Image size 2228x1652. CFP. Posterior pole field covering the optic disc and macula. 50° field of view. Captured after pupil dilation. Acquired with a Topcon TRC-50DX: 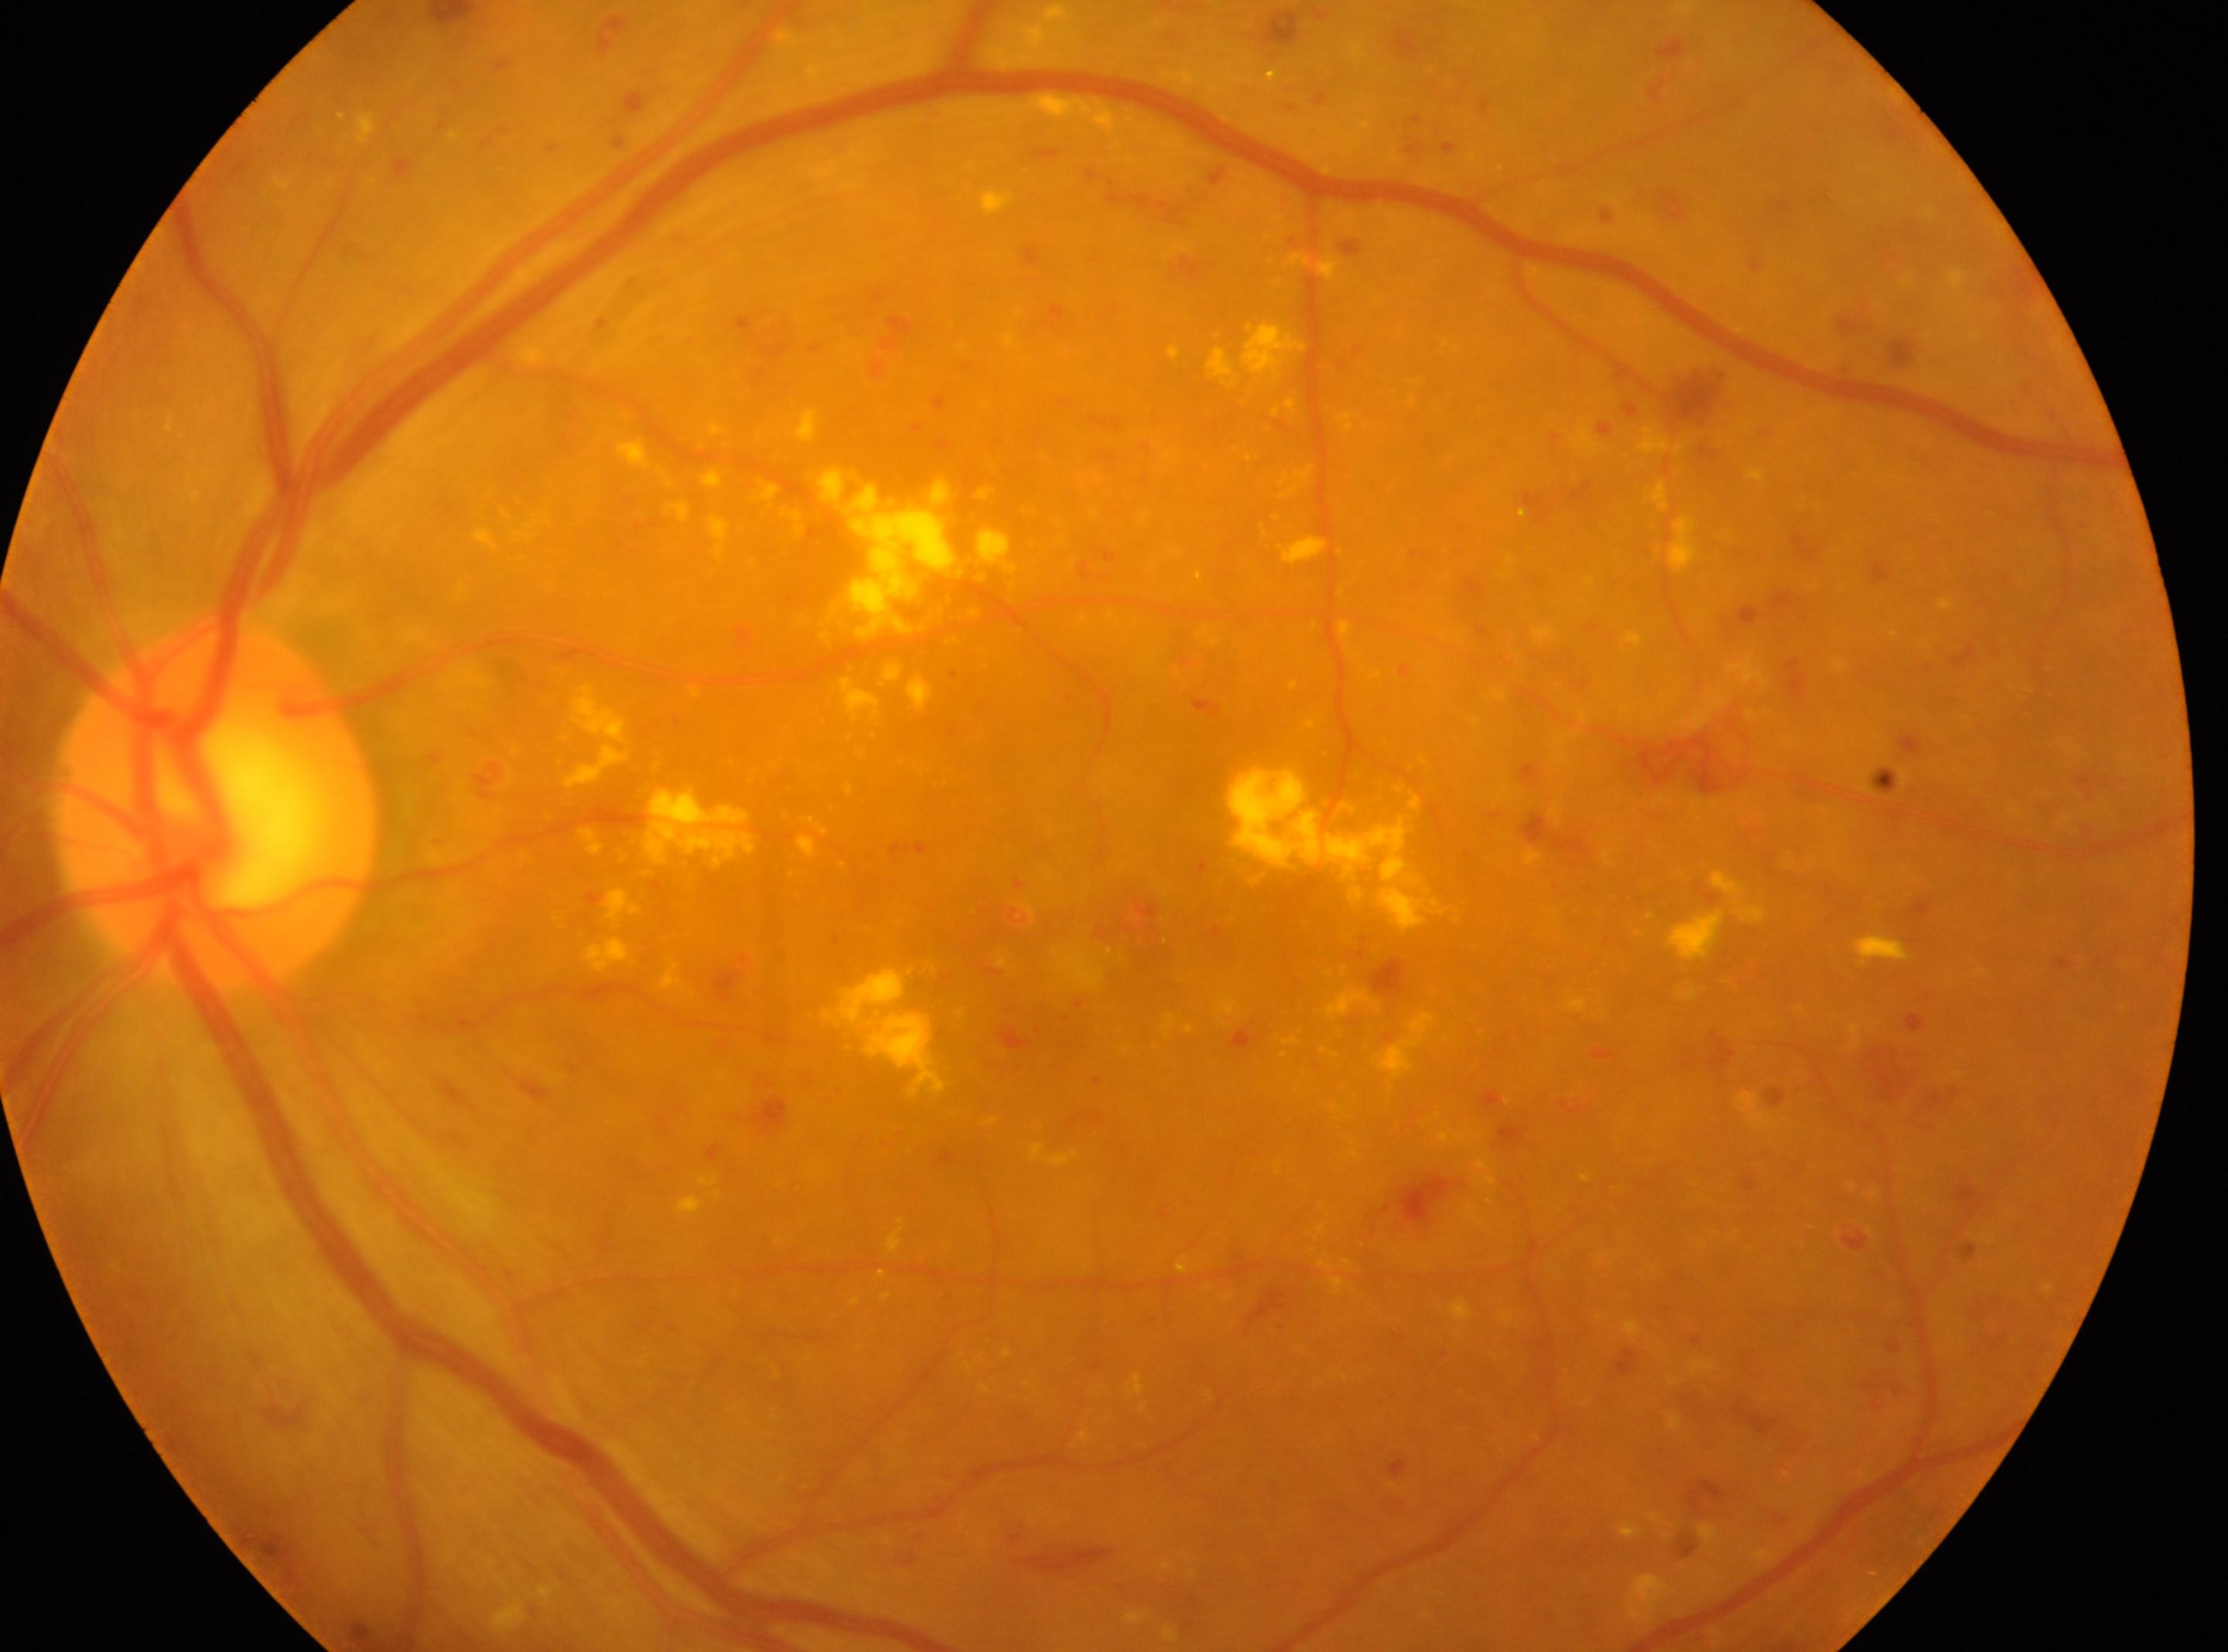

fovea center: x=1057, y=970
OS
optic disk: x=214, y=804
diabetic retinopathy grade: 3